FOV: 200 degrees; ultra-widefield fundus mosaic; 1924 x 1556 pixels.
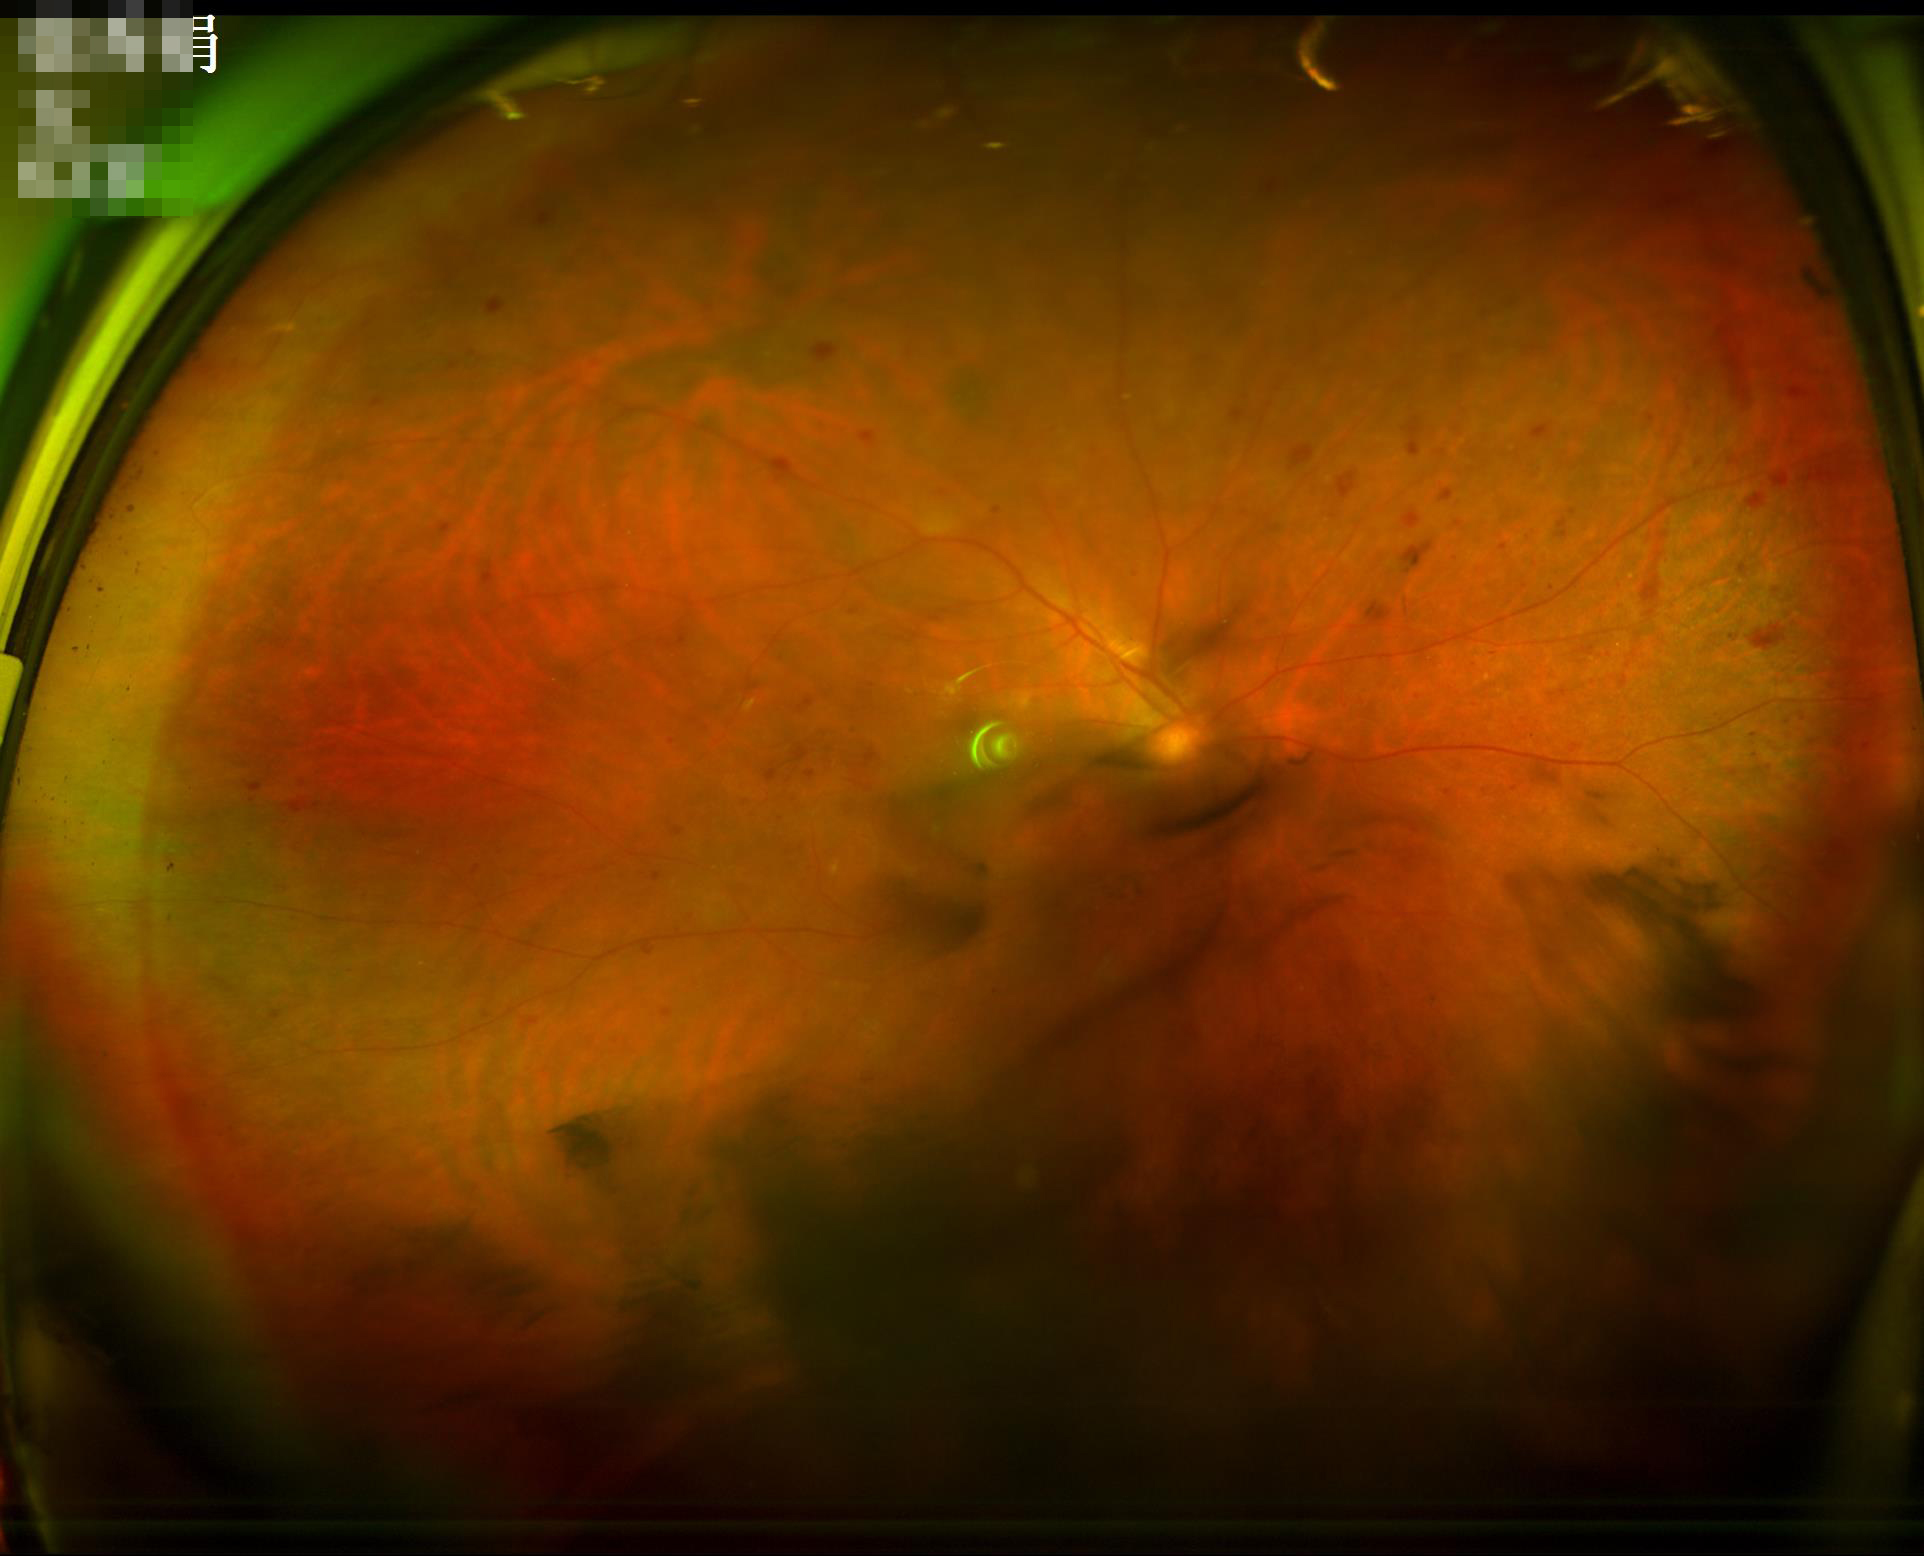
Sharpness = noticeable blur in the optic disc, vessels, or background; Illumination/color = over- or under-exposed; Overall = poor and difficult to use diagnostically; Contrast = wide intensity range, structures distinguishable.